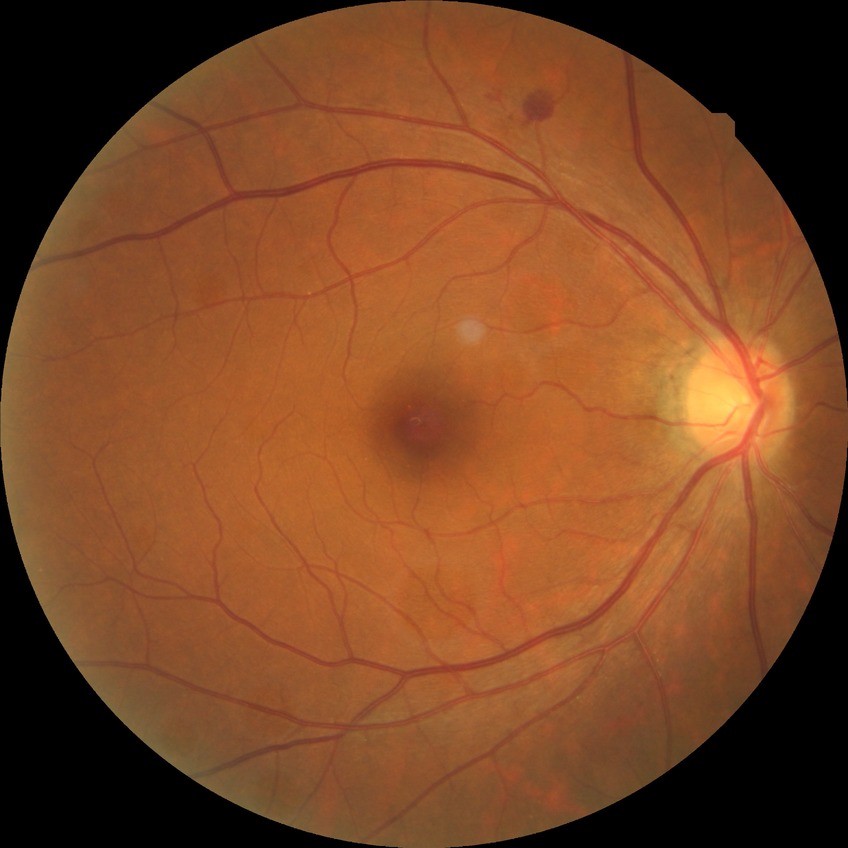
DR stage: SDR.